Pediatric wide-field fundus photograph; camera: Clarity RetCam 3 (130° FOV) — 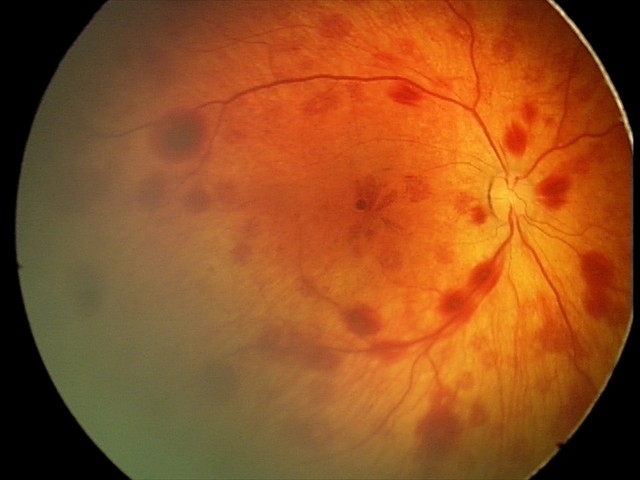 Q: What is the screening diagnosis?
A: retinal hemorrhages